Color fundus photograph:
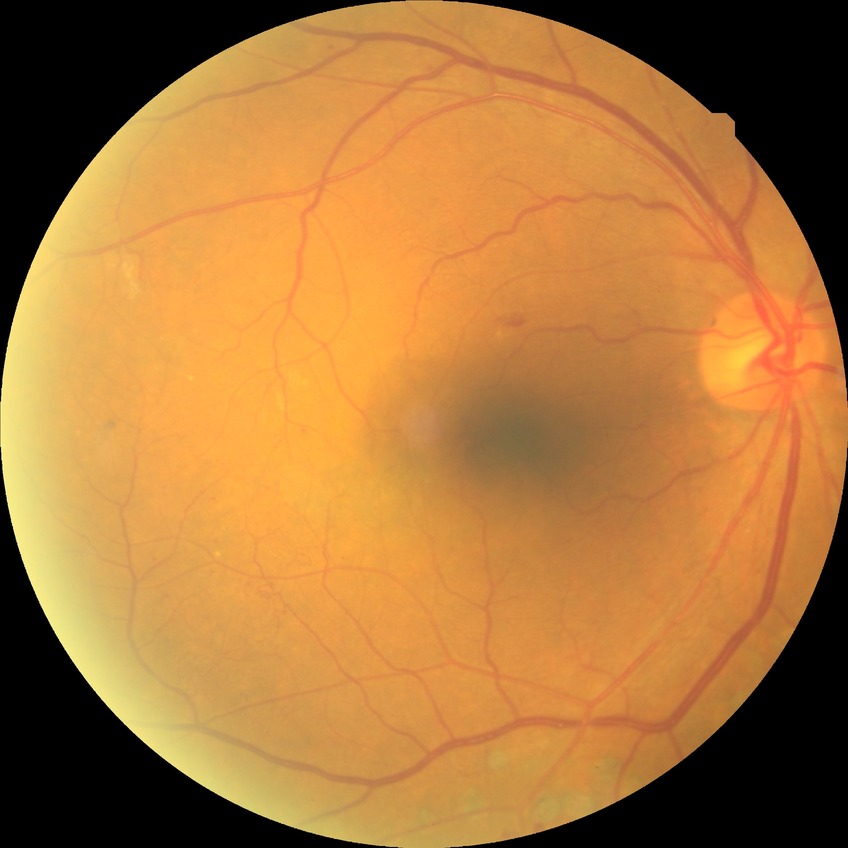

DR grade: PDR.